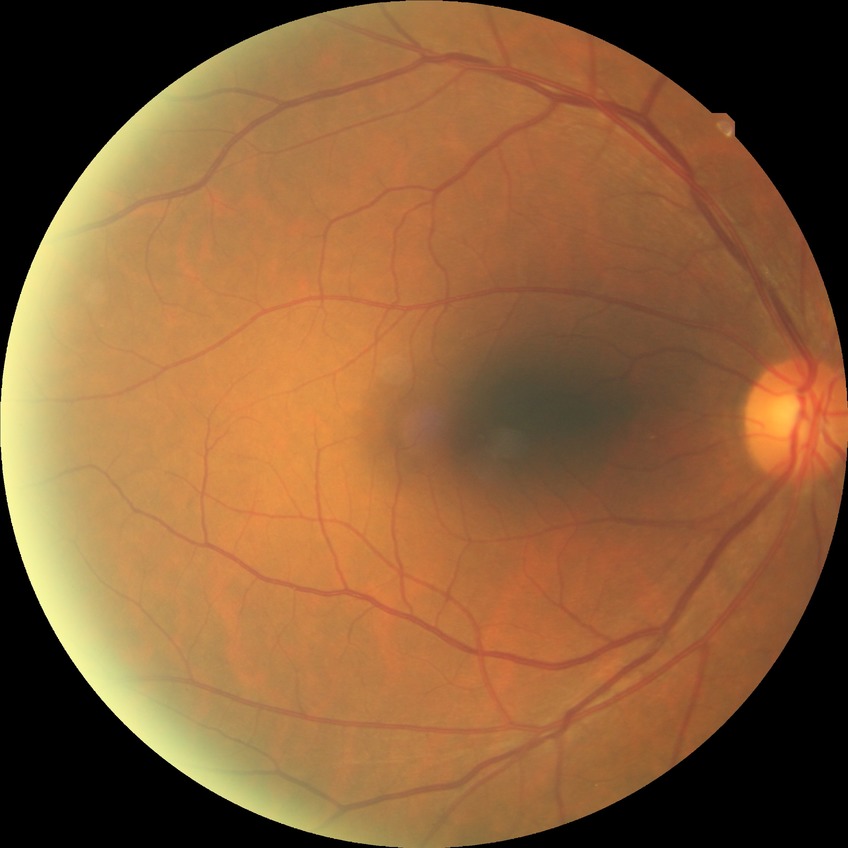 Diabetic retinopathy (DR) is NDR (no diabetic retinopathy).